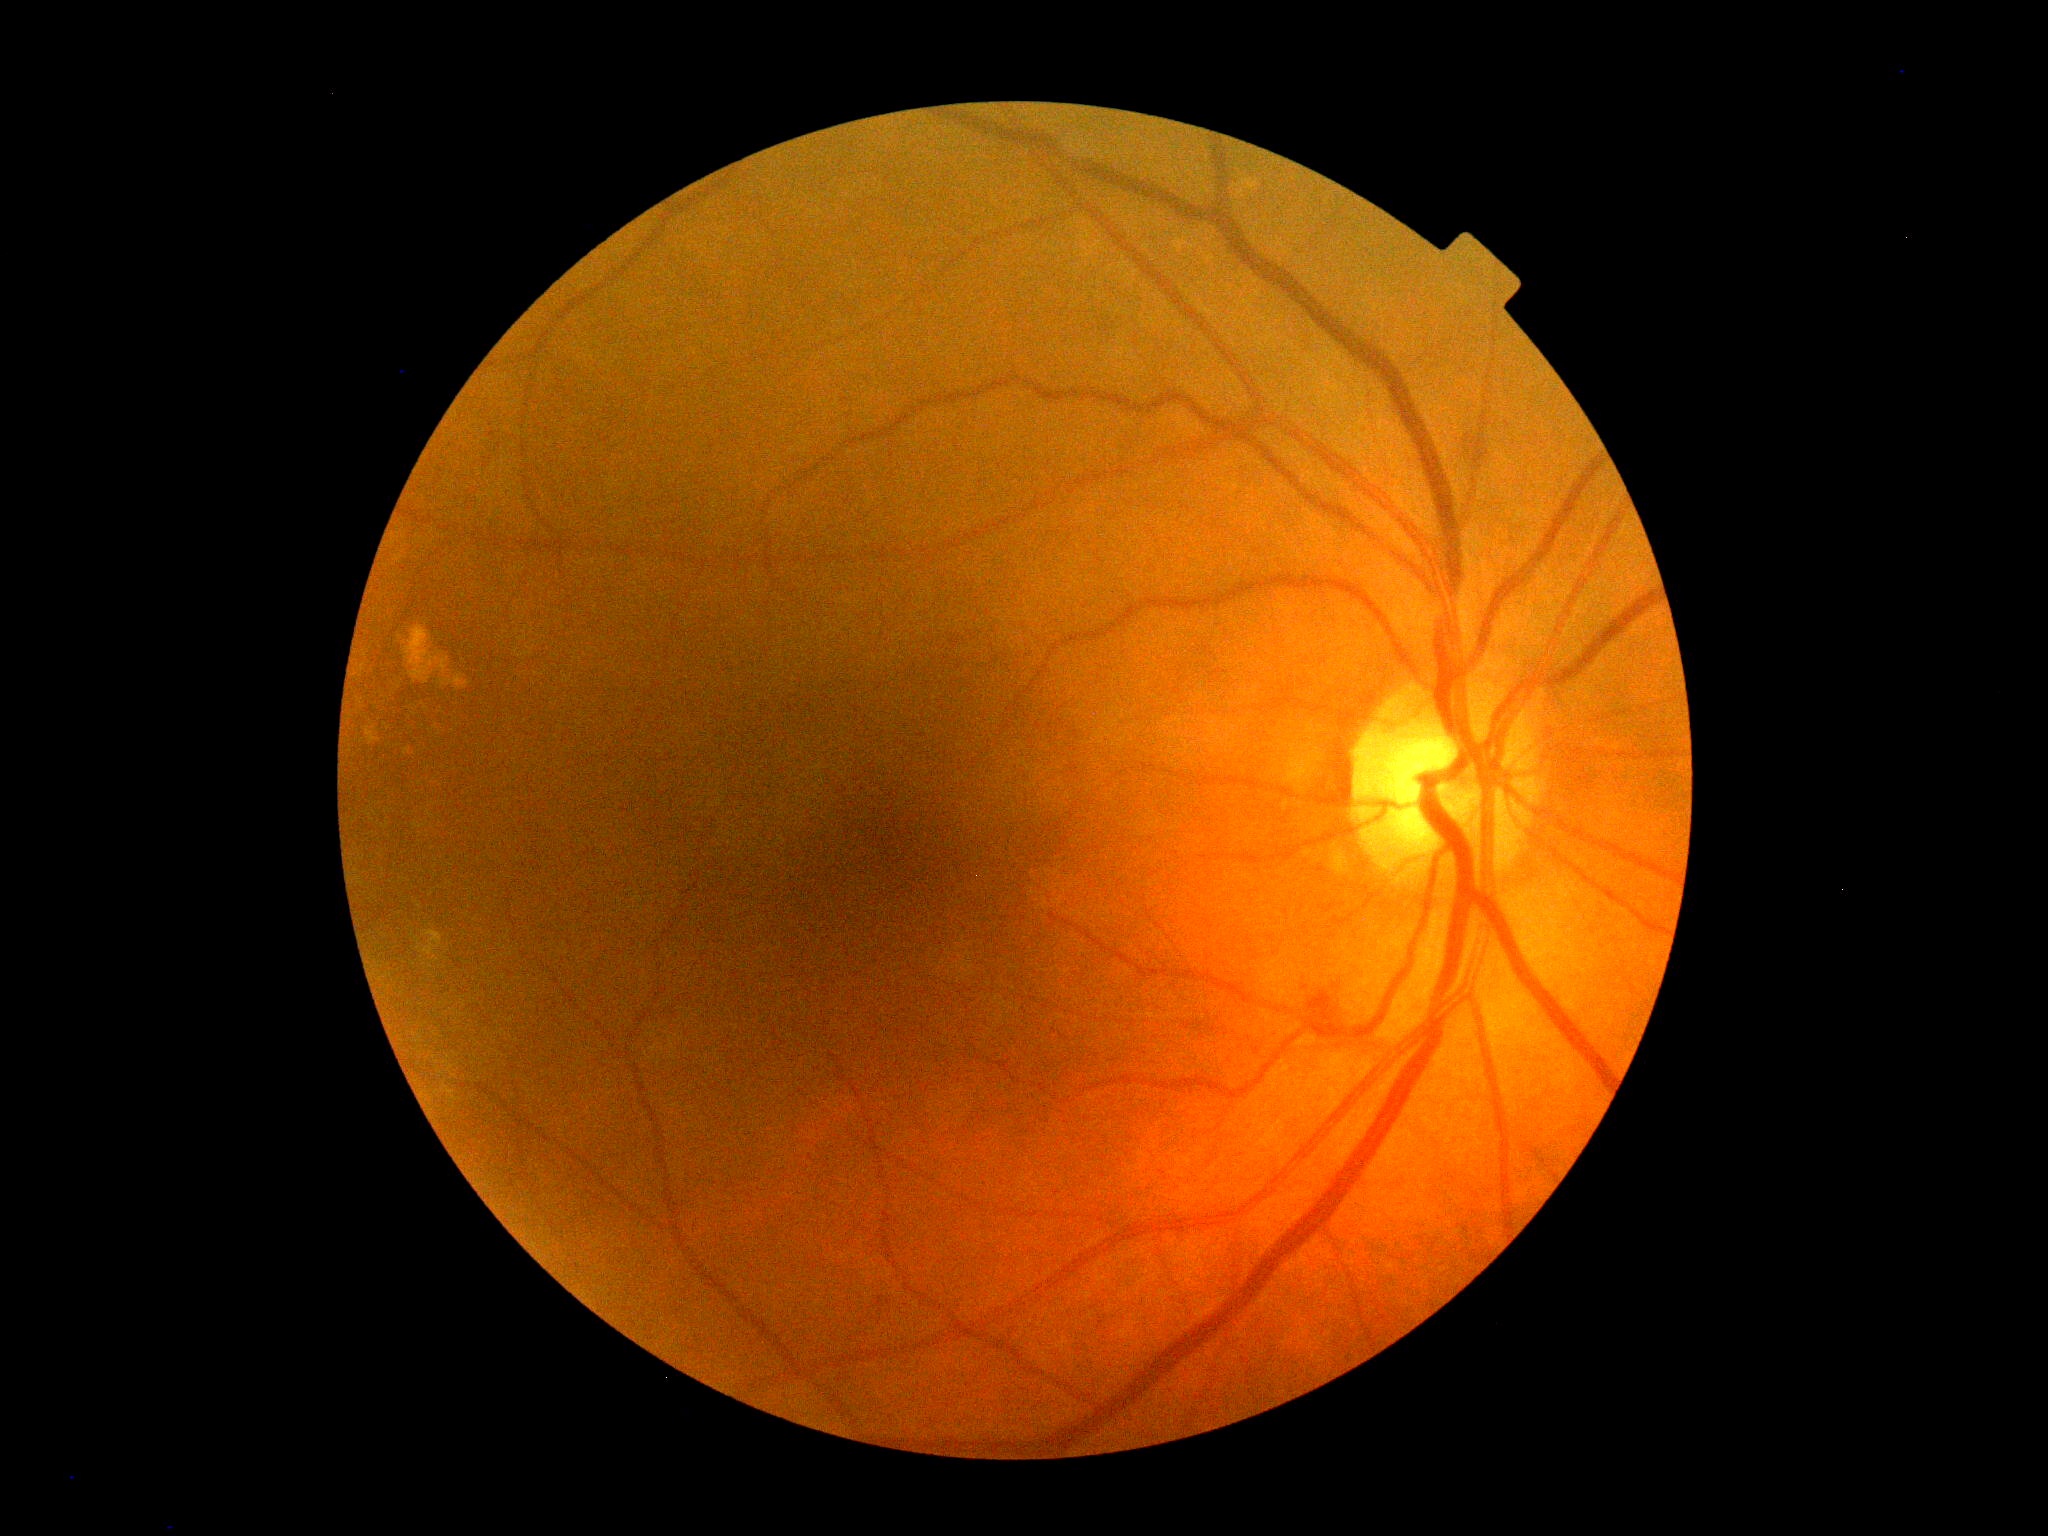

DR = grade 2 (moderate NPDR).